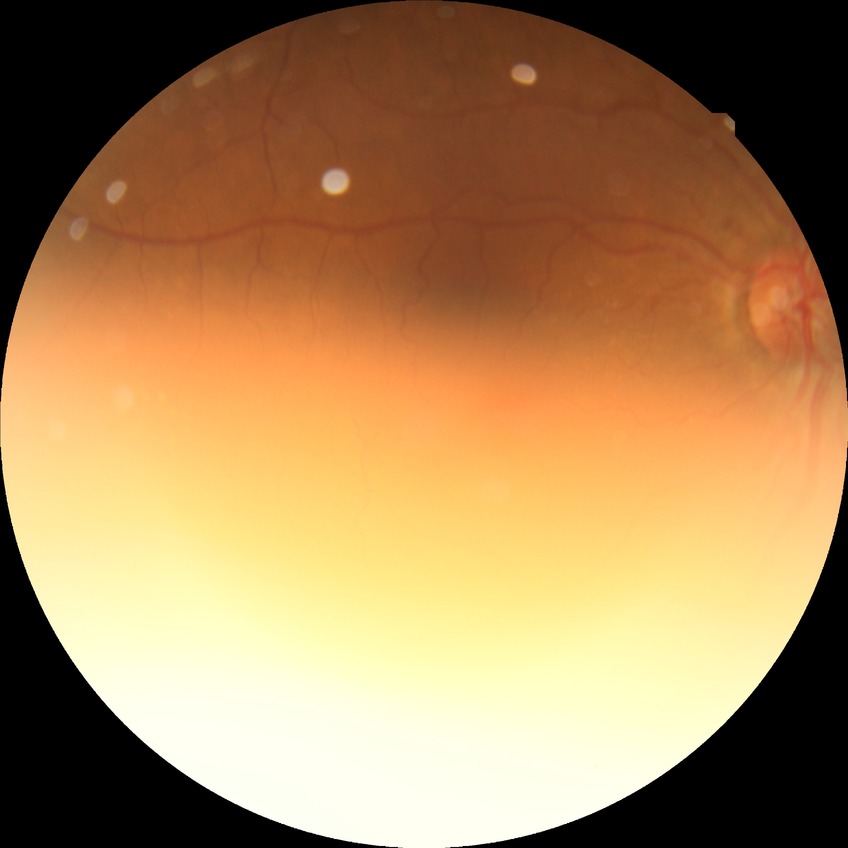

Assessment:
- diabetic retinopathy (DR) — NDR (no diabetic retinopathy)